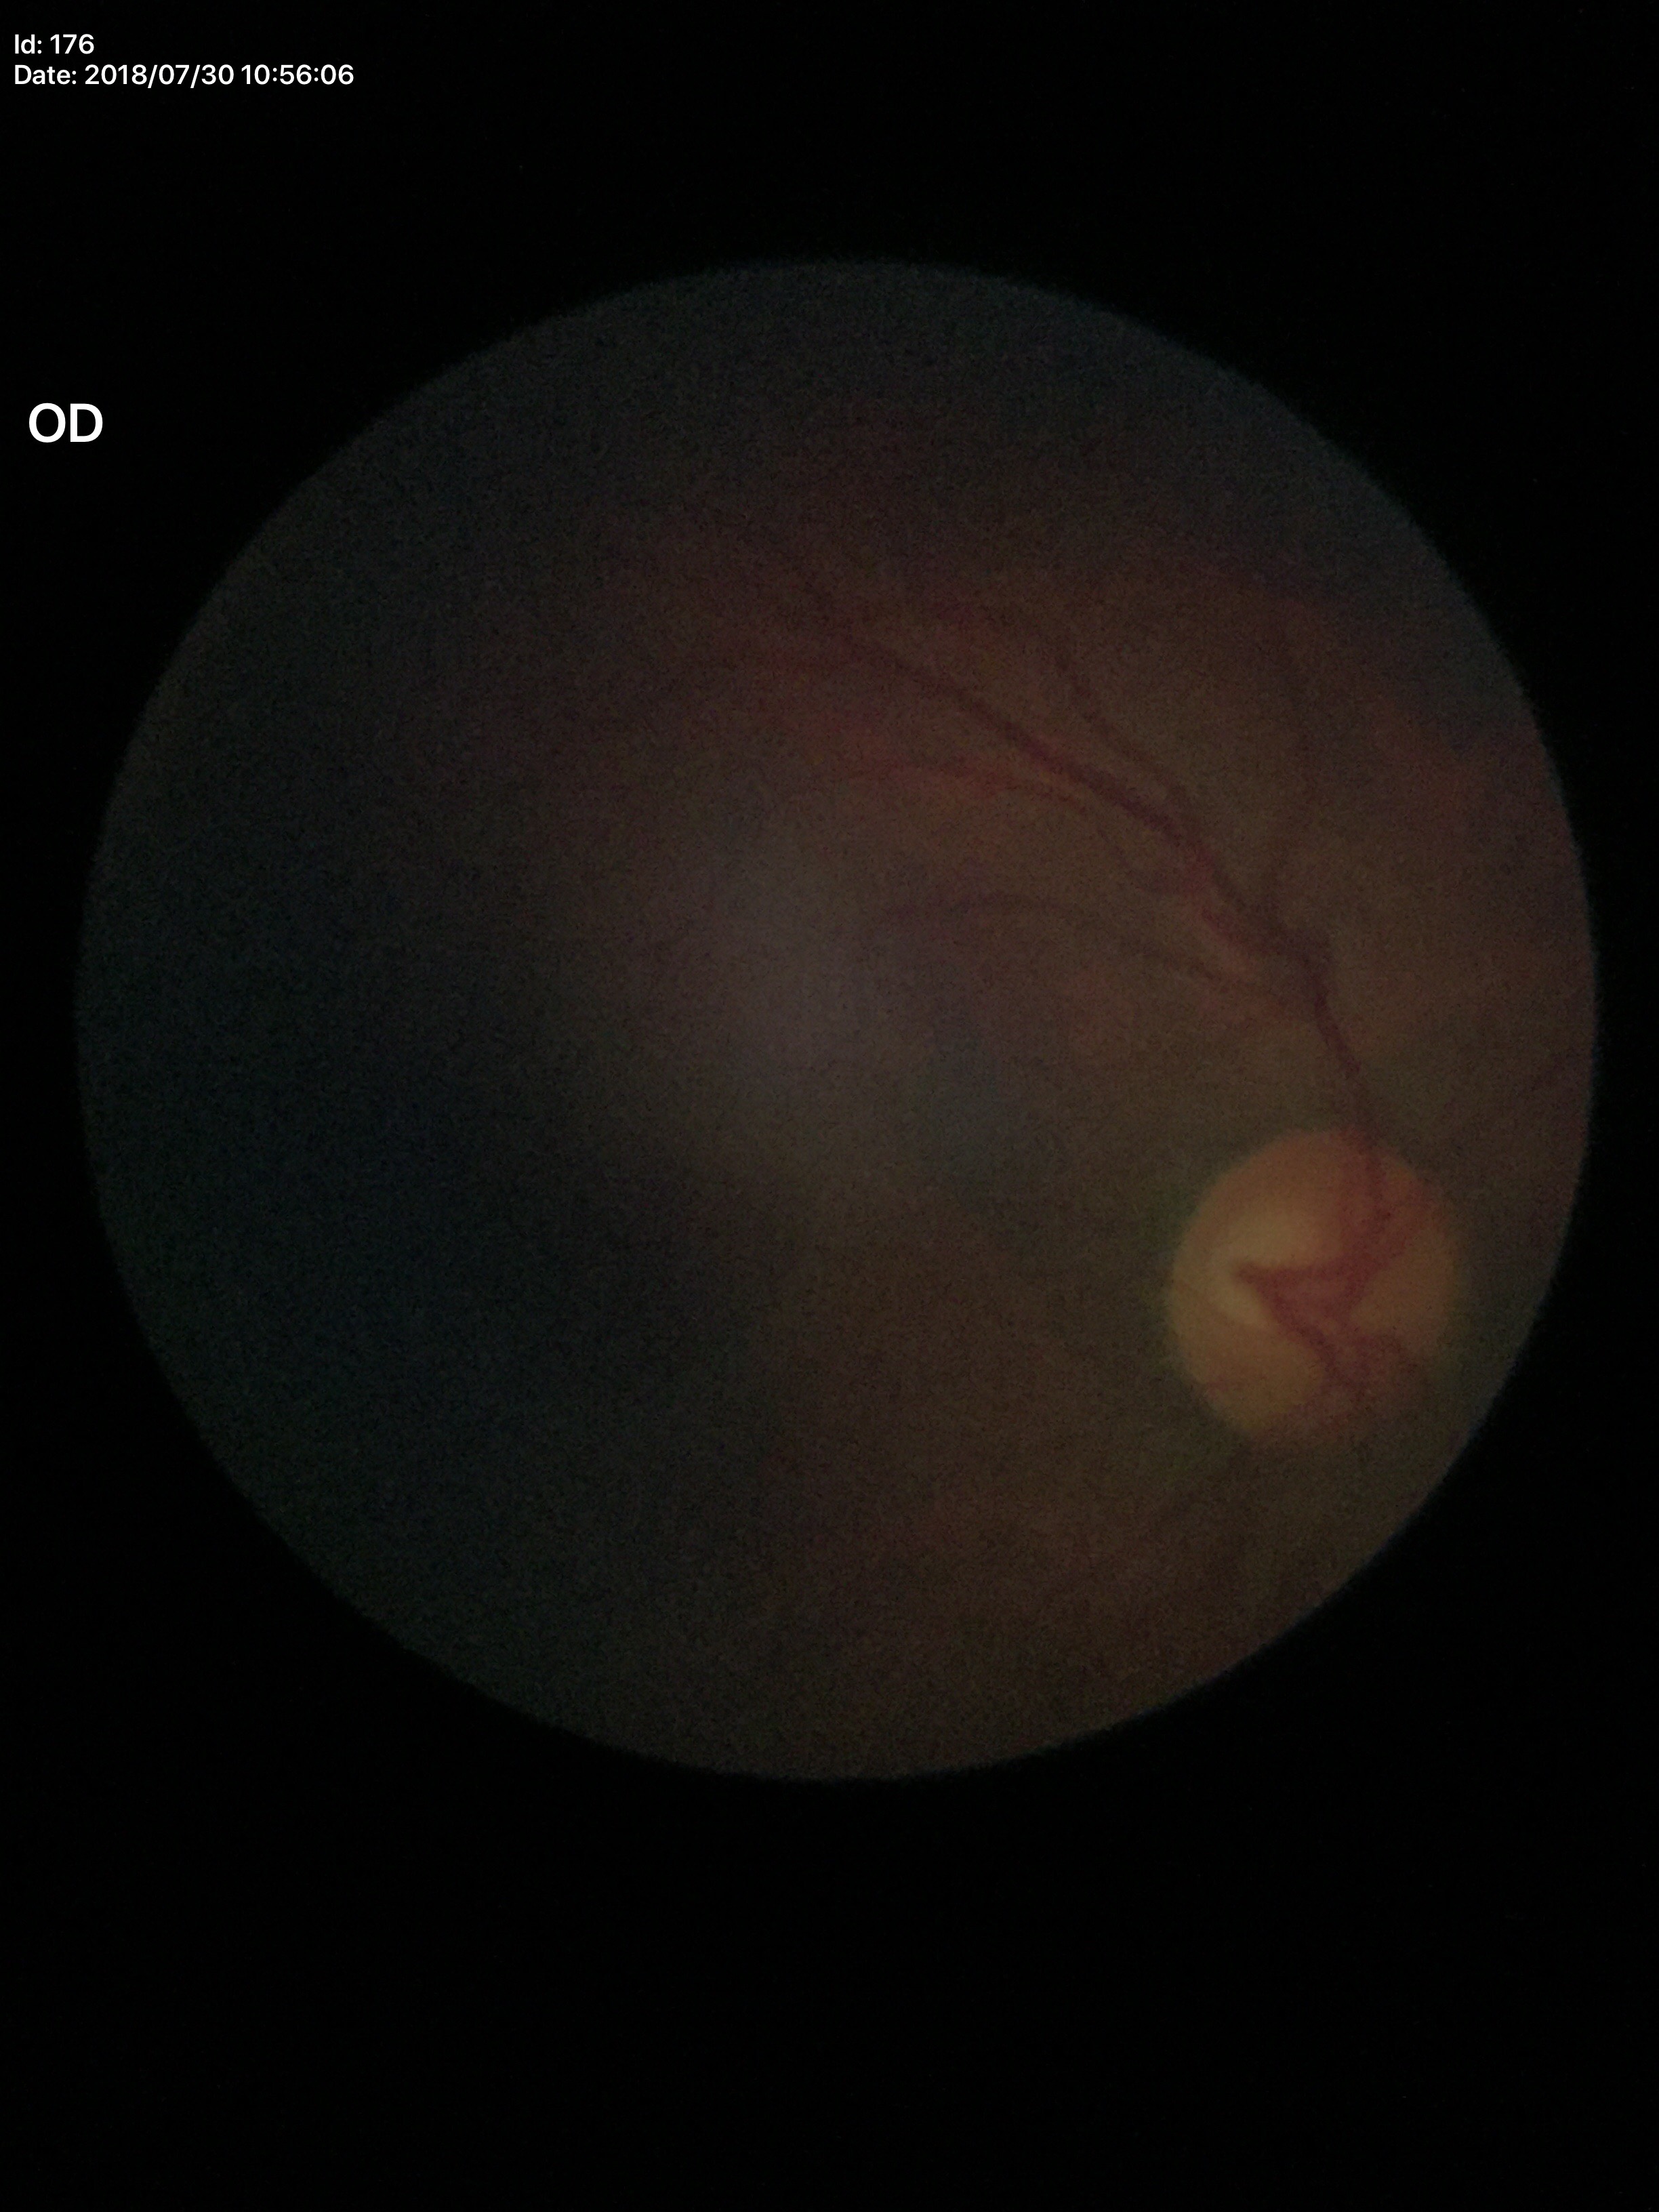

Suspicious for glaucoma.
Area cup-disc ratio (ACDR) is 0.41.
Vertical C/D ratio (VCDR): 0.61.